Davis DR grading · fundus photo: 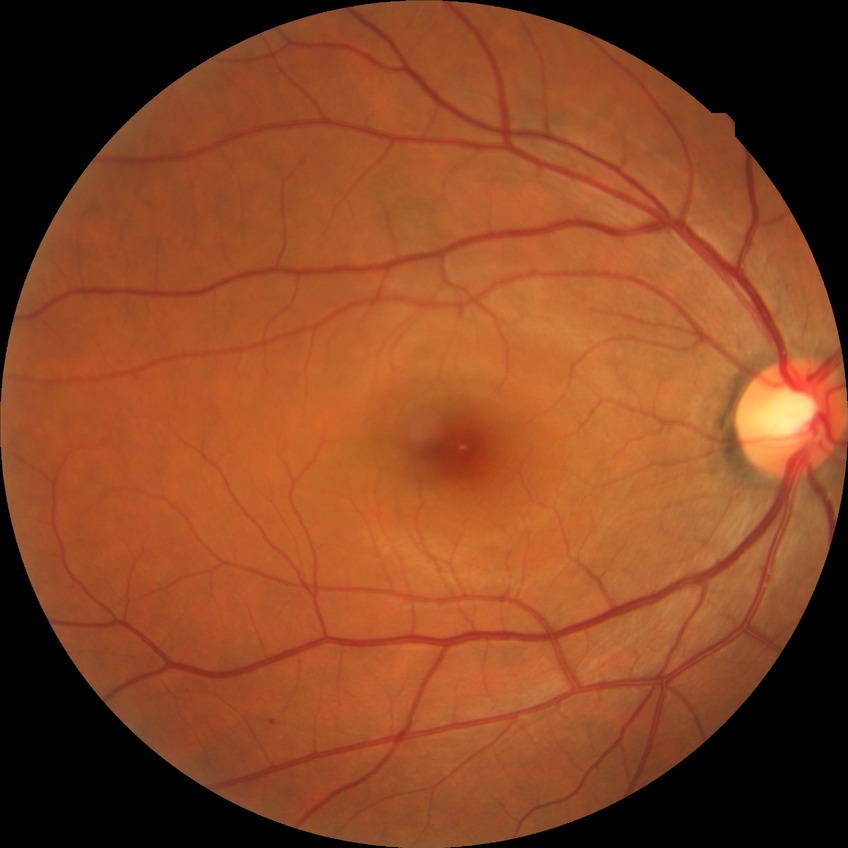

DR class: non-proliferative diabetic retinopathy.
Retinopathy stage: simple diabetic retinopathy.